Pediatric wide-field fundus photograph
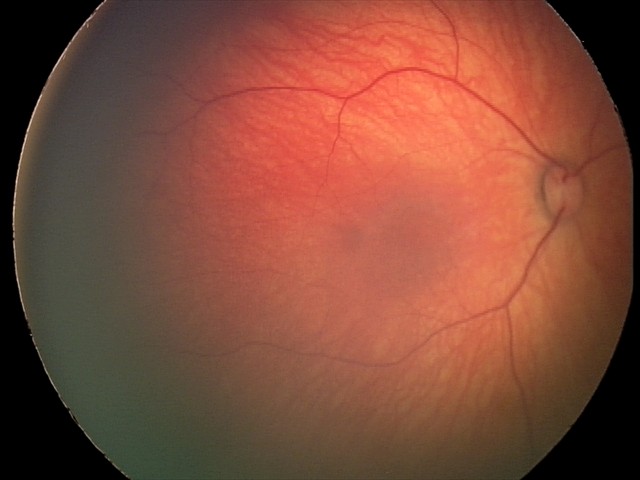

Screening series with retinal hemorrhages.